Modified Davis grading; without pupil dilation — 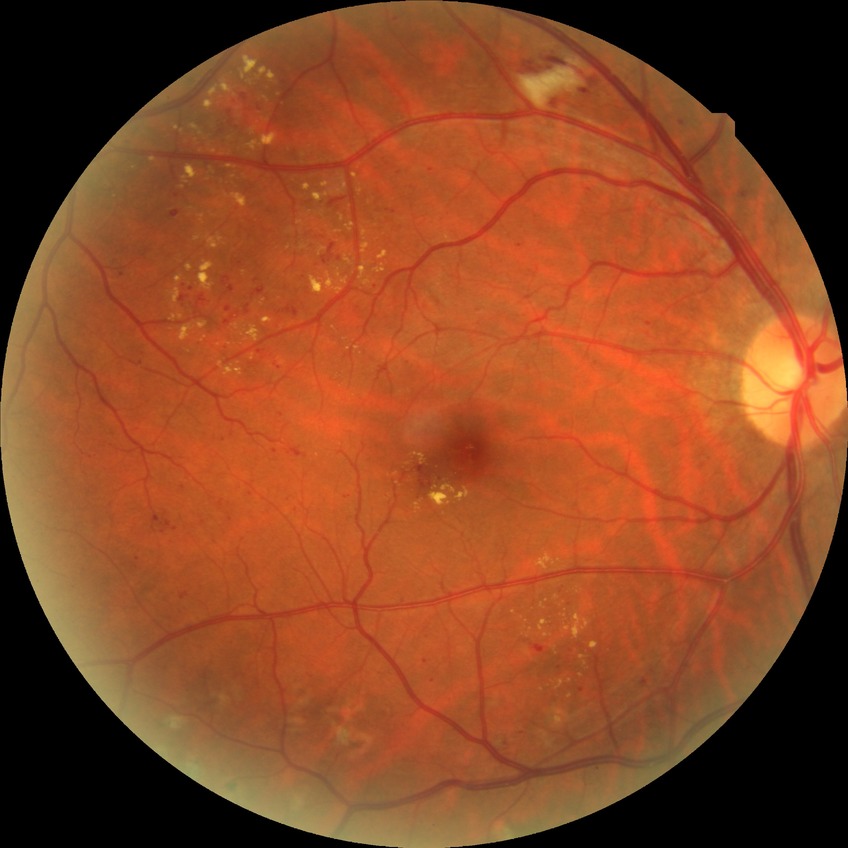

retinopathy grade@simple diabetic retinopathy.